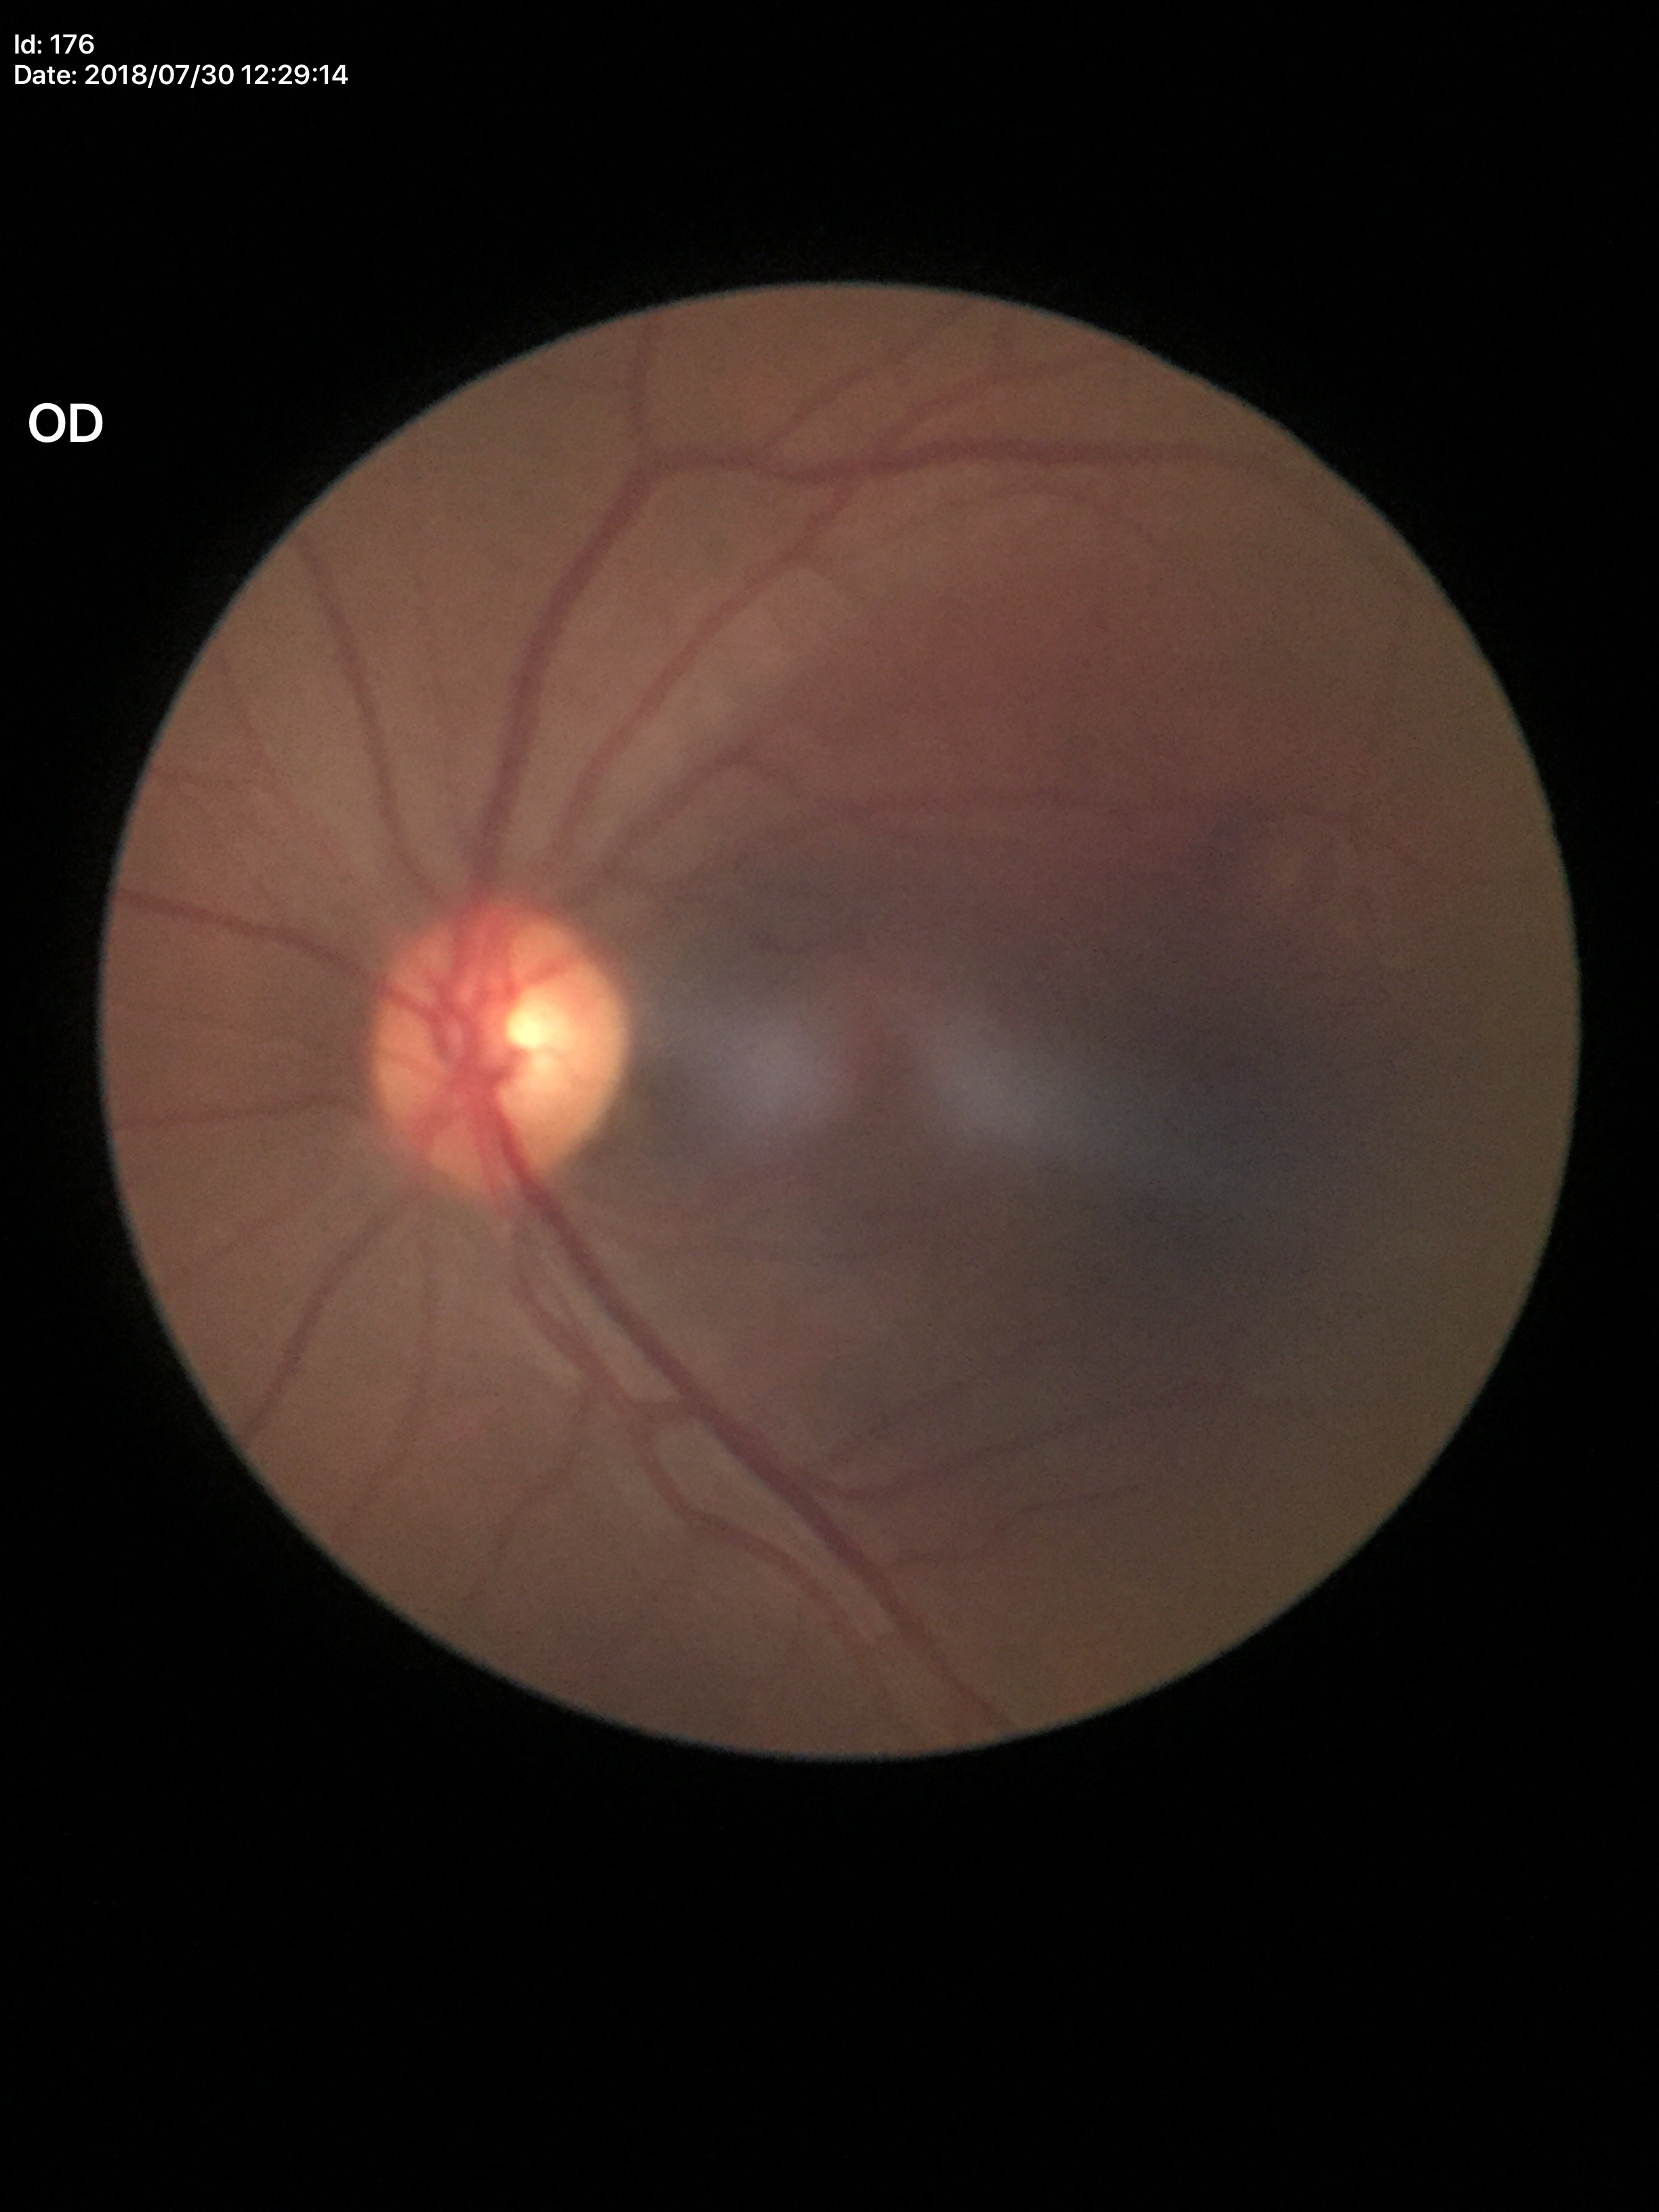
Glaucoma evaluation: not suspect
vertical cup-to-disc ratio: 0.56